Image size 1924x1556.
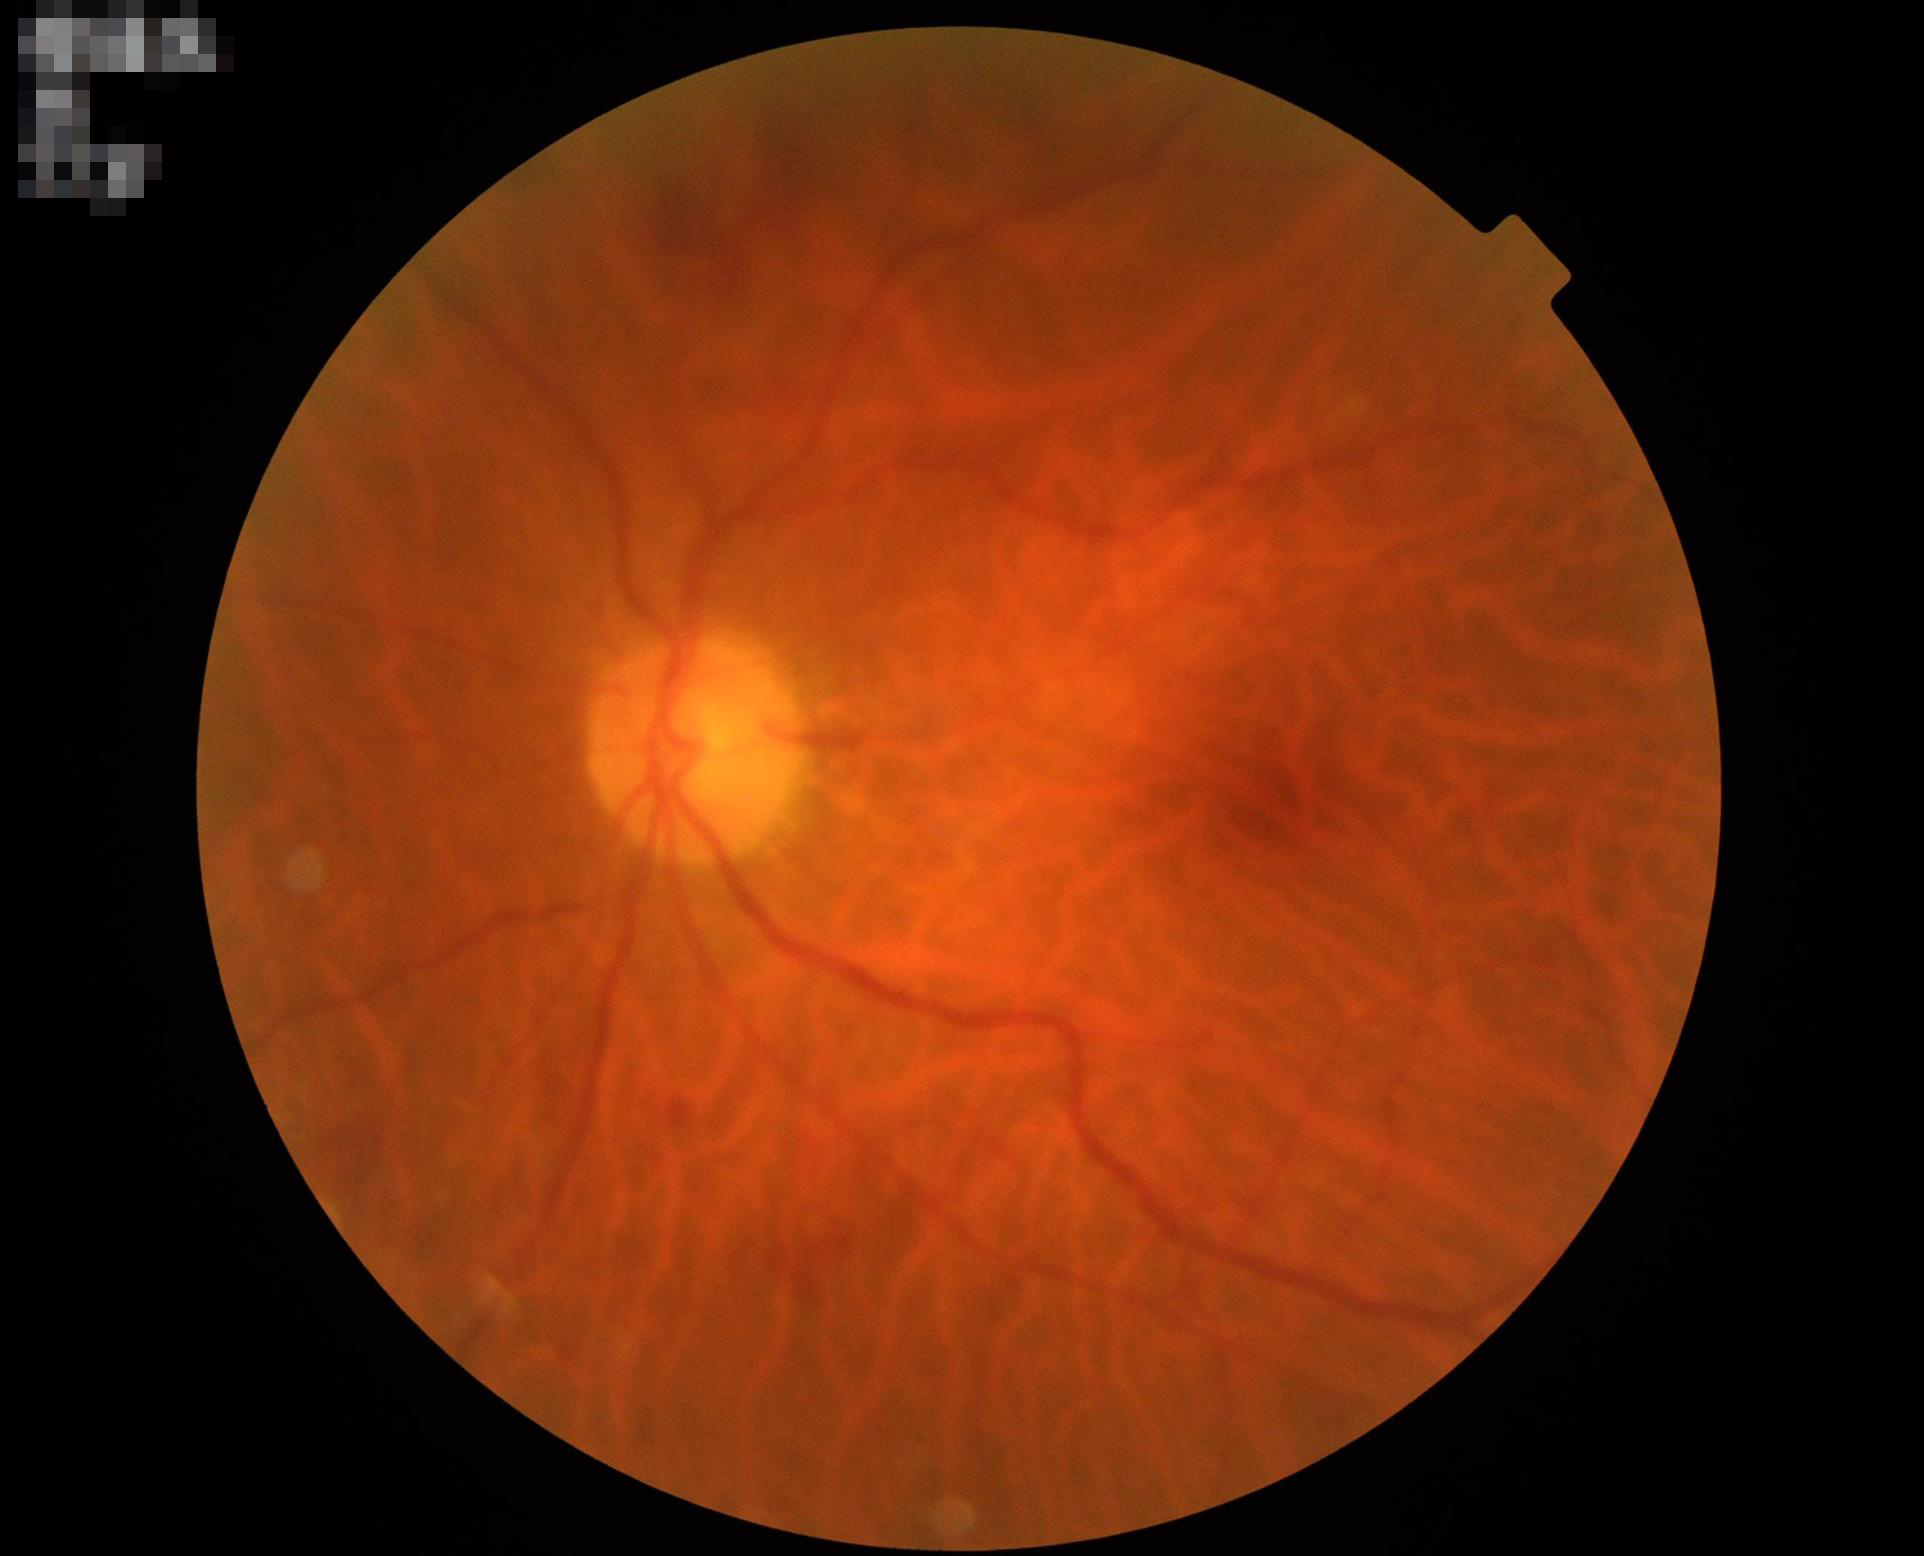 Quality grading:
- illumination: even
- overall: satisfactory